Captured with the Clarity RetCam 3 (130° field of view) · RetCam wide-field infant fundus image · image size 640x480 — 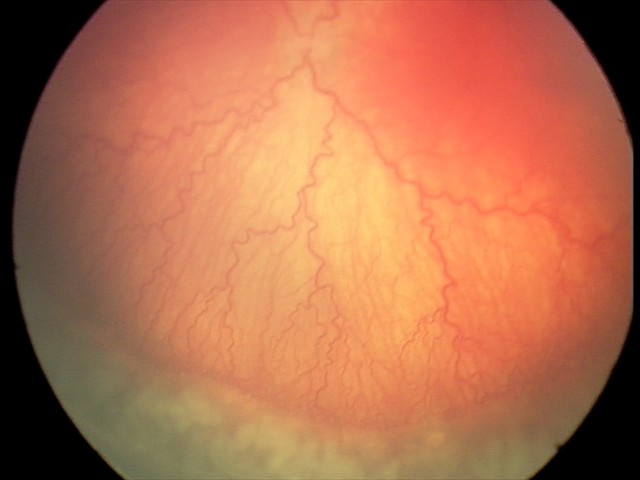

Examination diagnosed as A-ROP (aggressive ROP) — rapidly progressive severe ROP with prominent plus disease, often without classic stage progression.